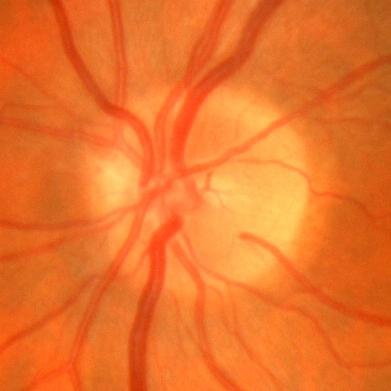

Glaucoma status = no glaucomatous changes.